Pediatric wide-field fundus photograph. 1240x1240px — 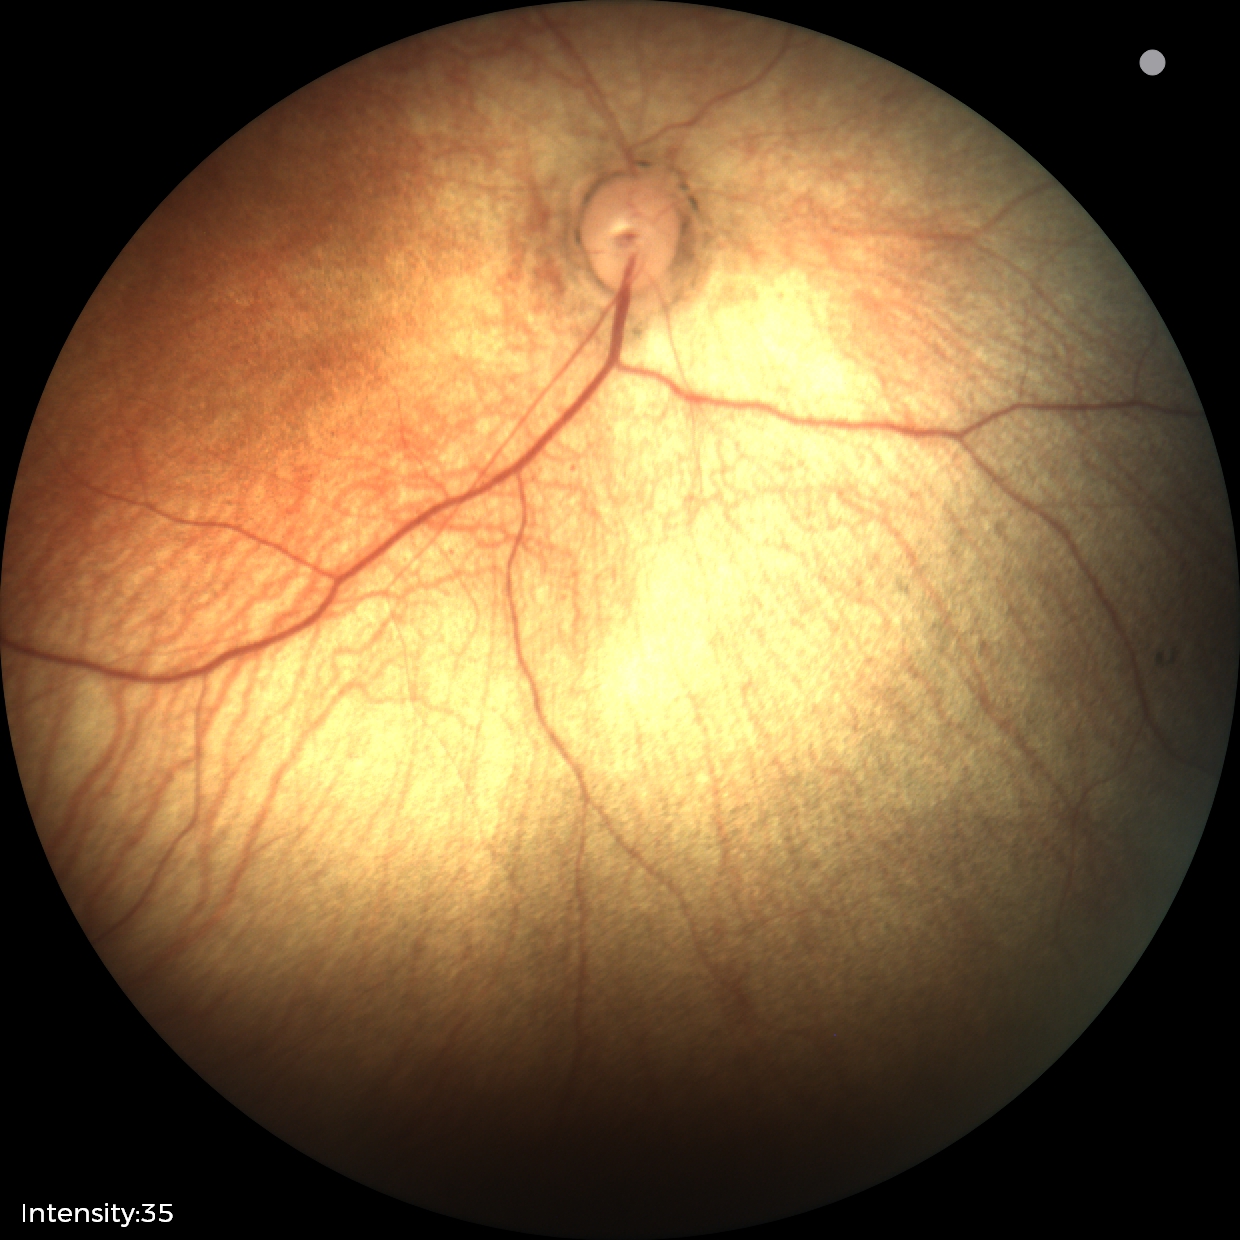 Screening examination with no abnormal retinal findings.